CFP:
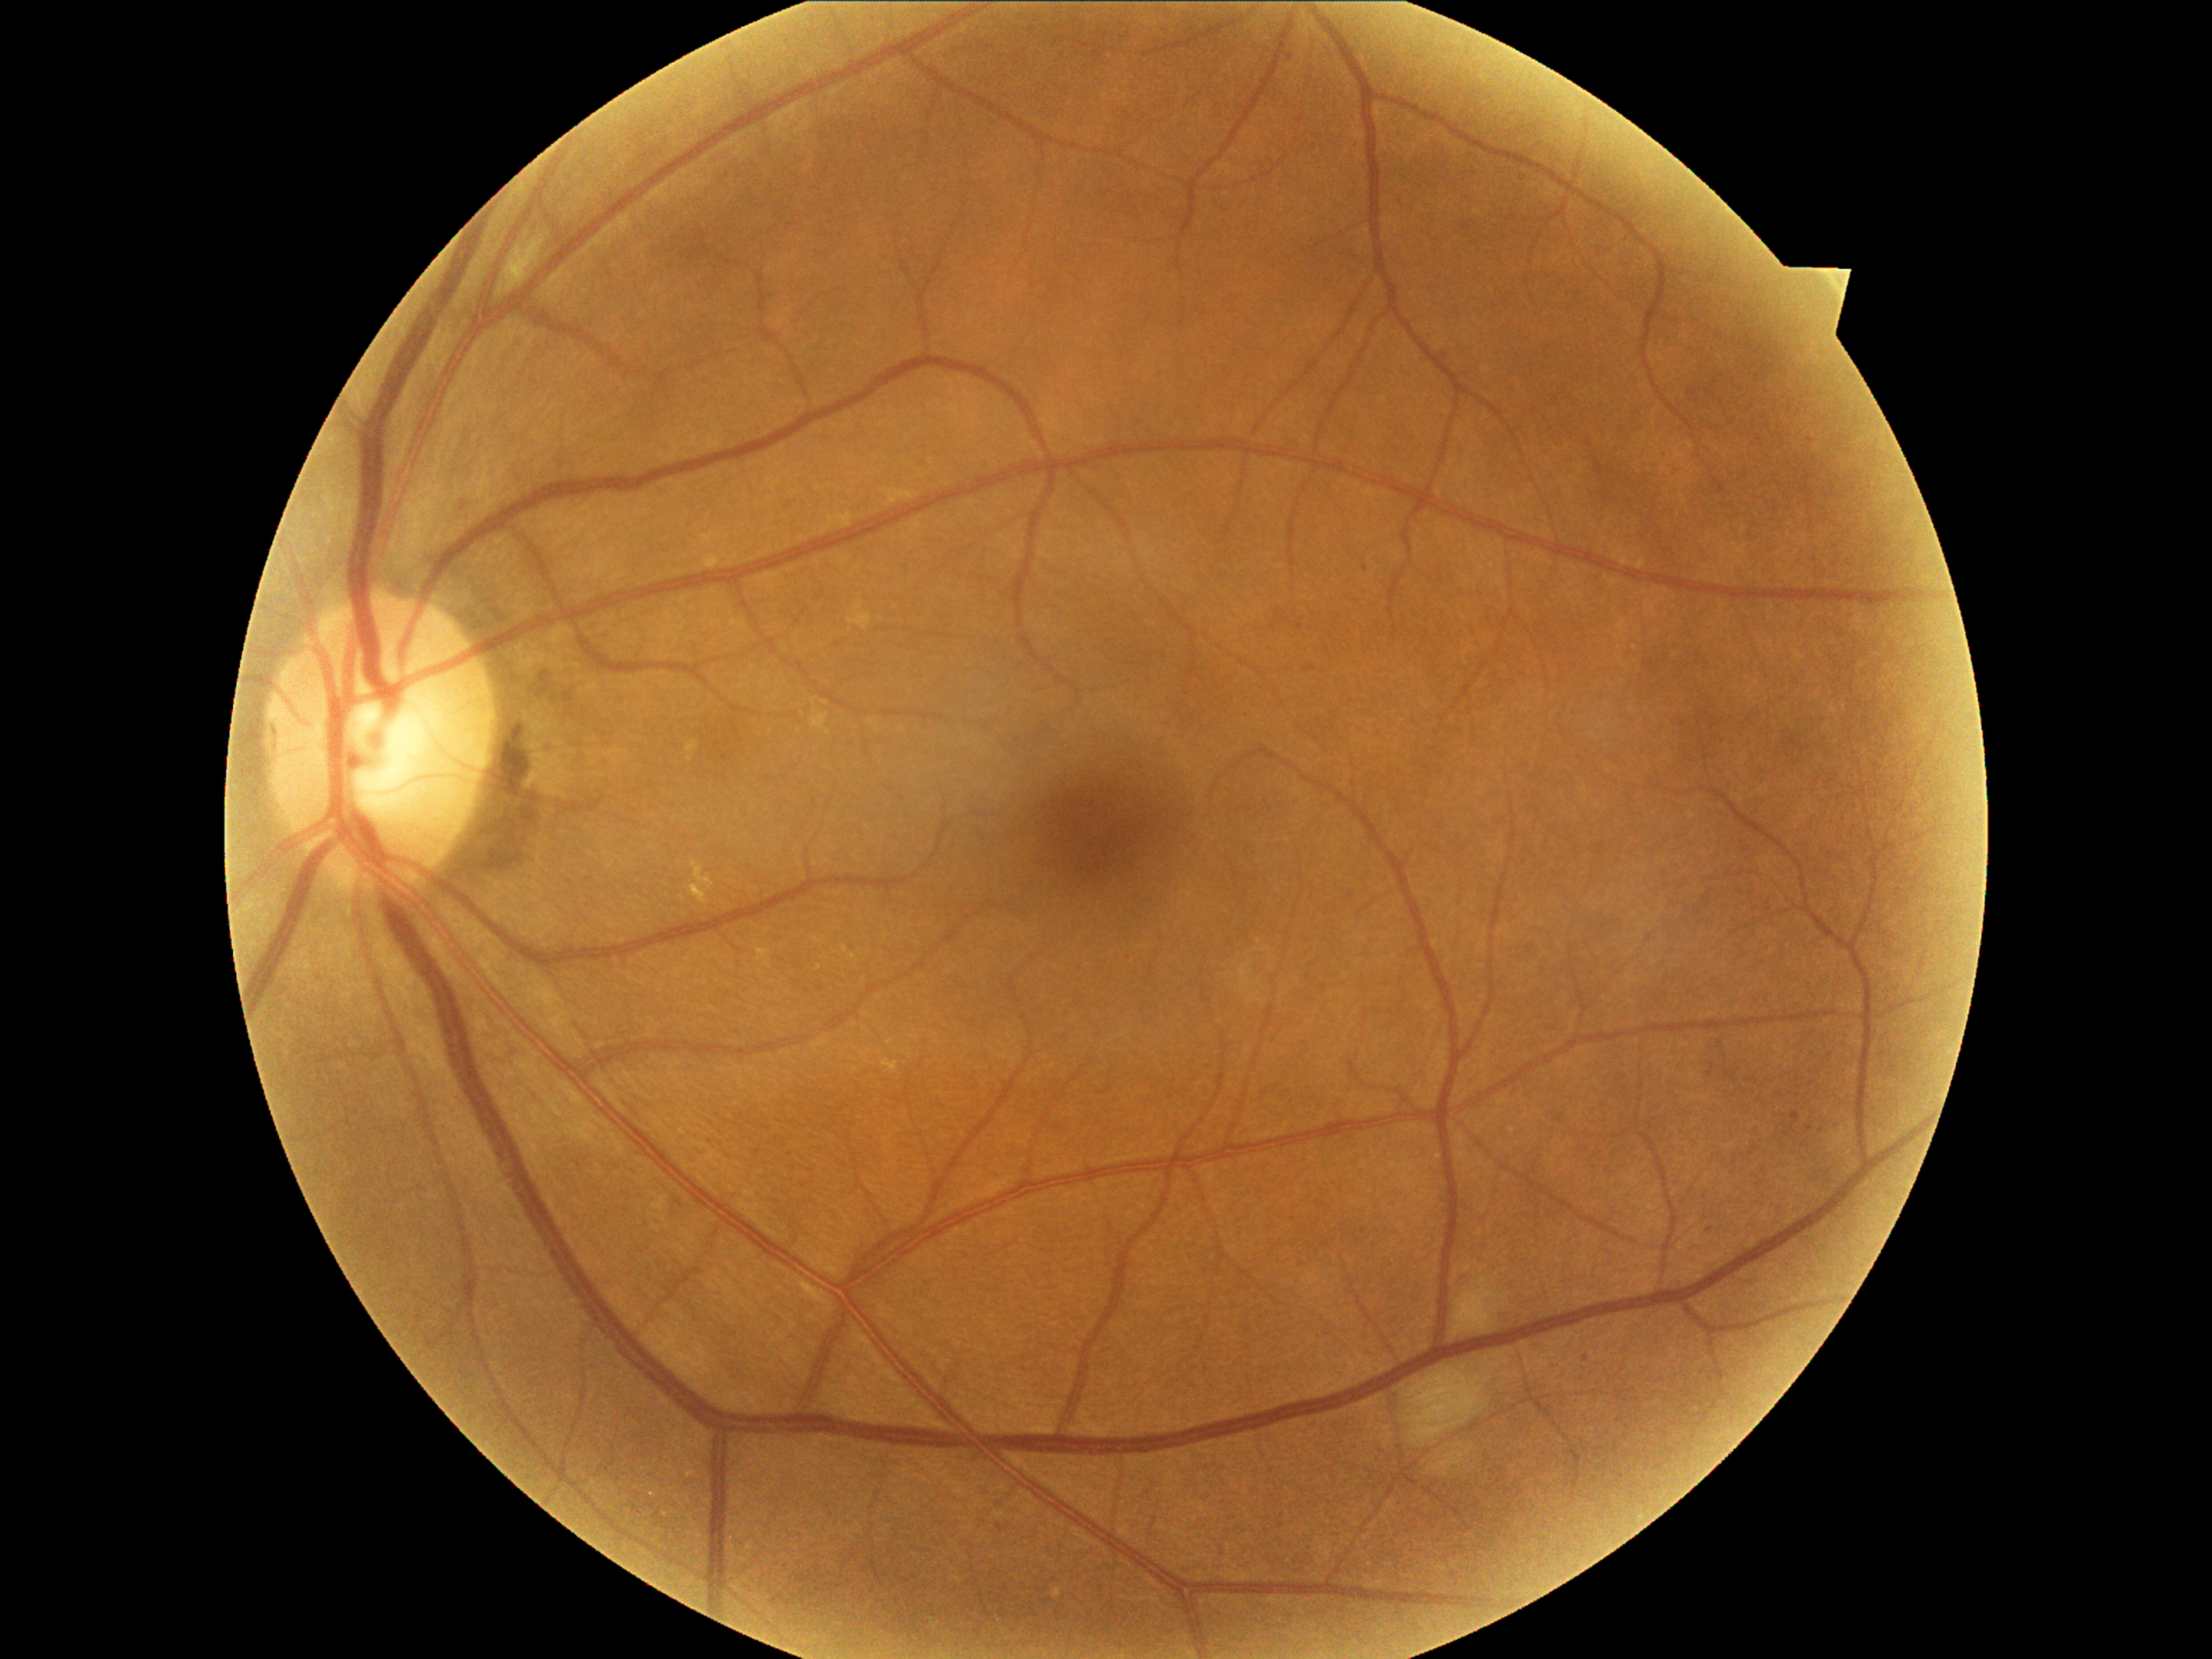
DR is moderate non-proliferative diabetic retinopathy (grade 2)
• HEs: none
• MAs: {"left": 1791, "top": 1112, "right": 1802, "bottom": 1132}, {"left": 1298, "top": 620, "right": 1305, "bottom": 631}
• MAs (small, approximate centers) near <pt>1365,569</pt>, <pt>1291,57</pt>, <pt>1709,1229</pt>, <pt>1585,1359</pt>, <pt>1001,1527</pt>
• EXs: {"left": 687, "top": 740, "right": 699, "bottom": 764}, {"left": 692, "top": 861, "right": 714, "bottom": 905}, {"left": 882, "top": 1059, "right": 899, "bottom": 1073}, {"left": 704, "top": 556, "right": 721, "bottom": 569}
• SEs: {"left": 1435, "top": 1447, "right": 1474, "bottom": 1477}, {"left": 1402, "top": 1368, "right": 1496, "bottom": 1448}, {"left": 1455, "top": 1272, "right": 1510, "bottom": 1336}